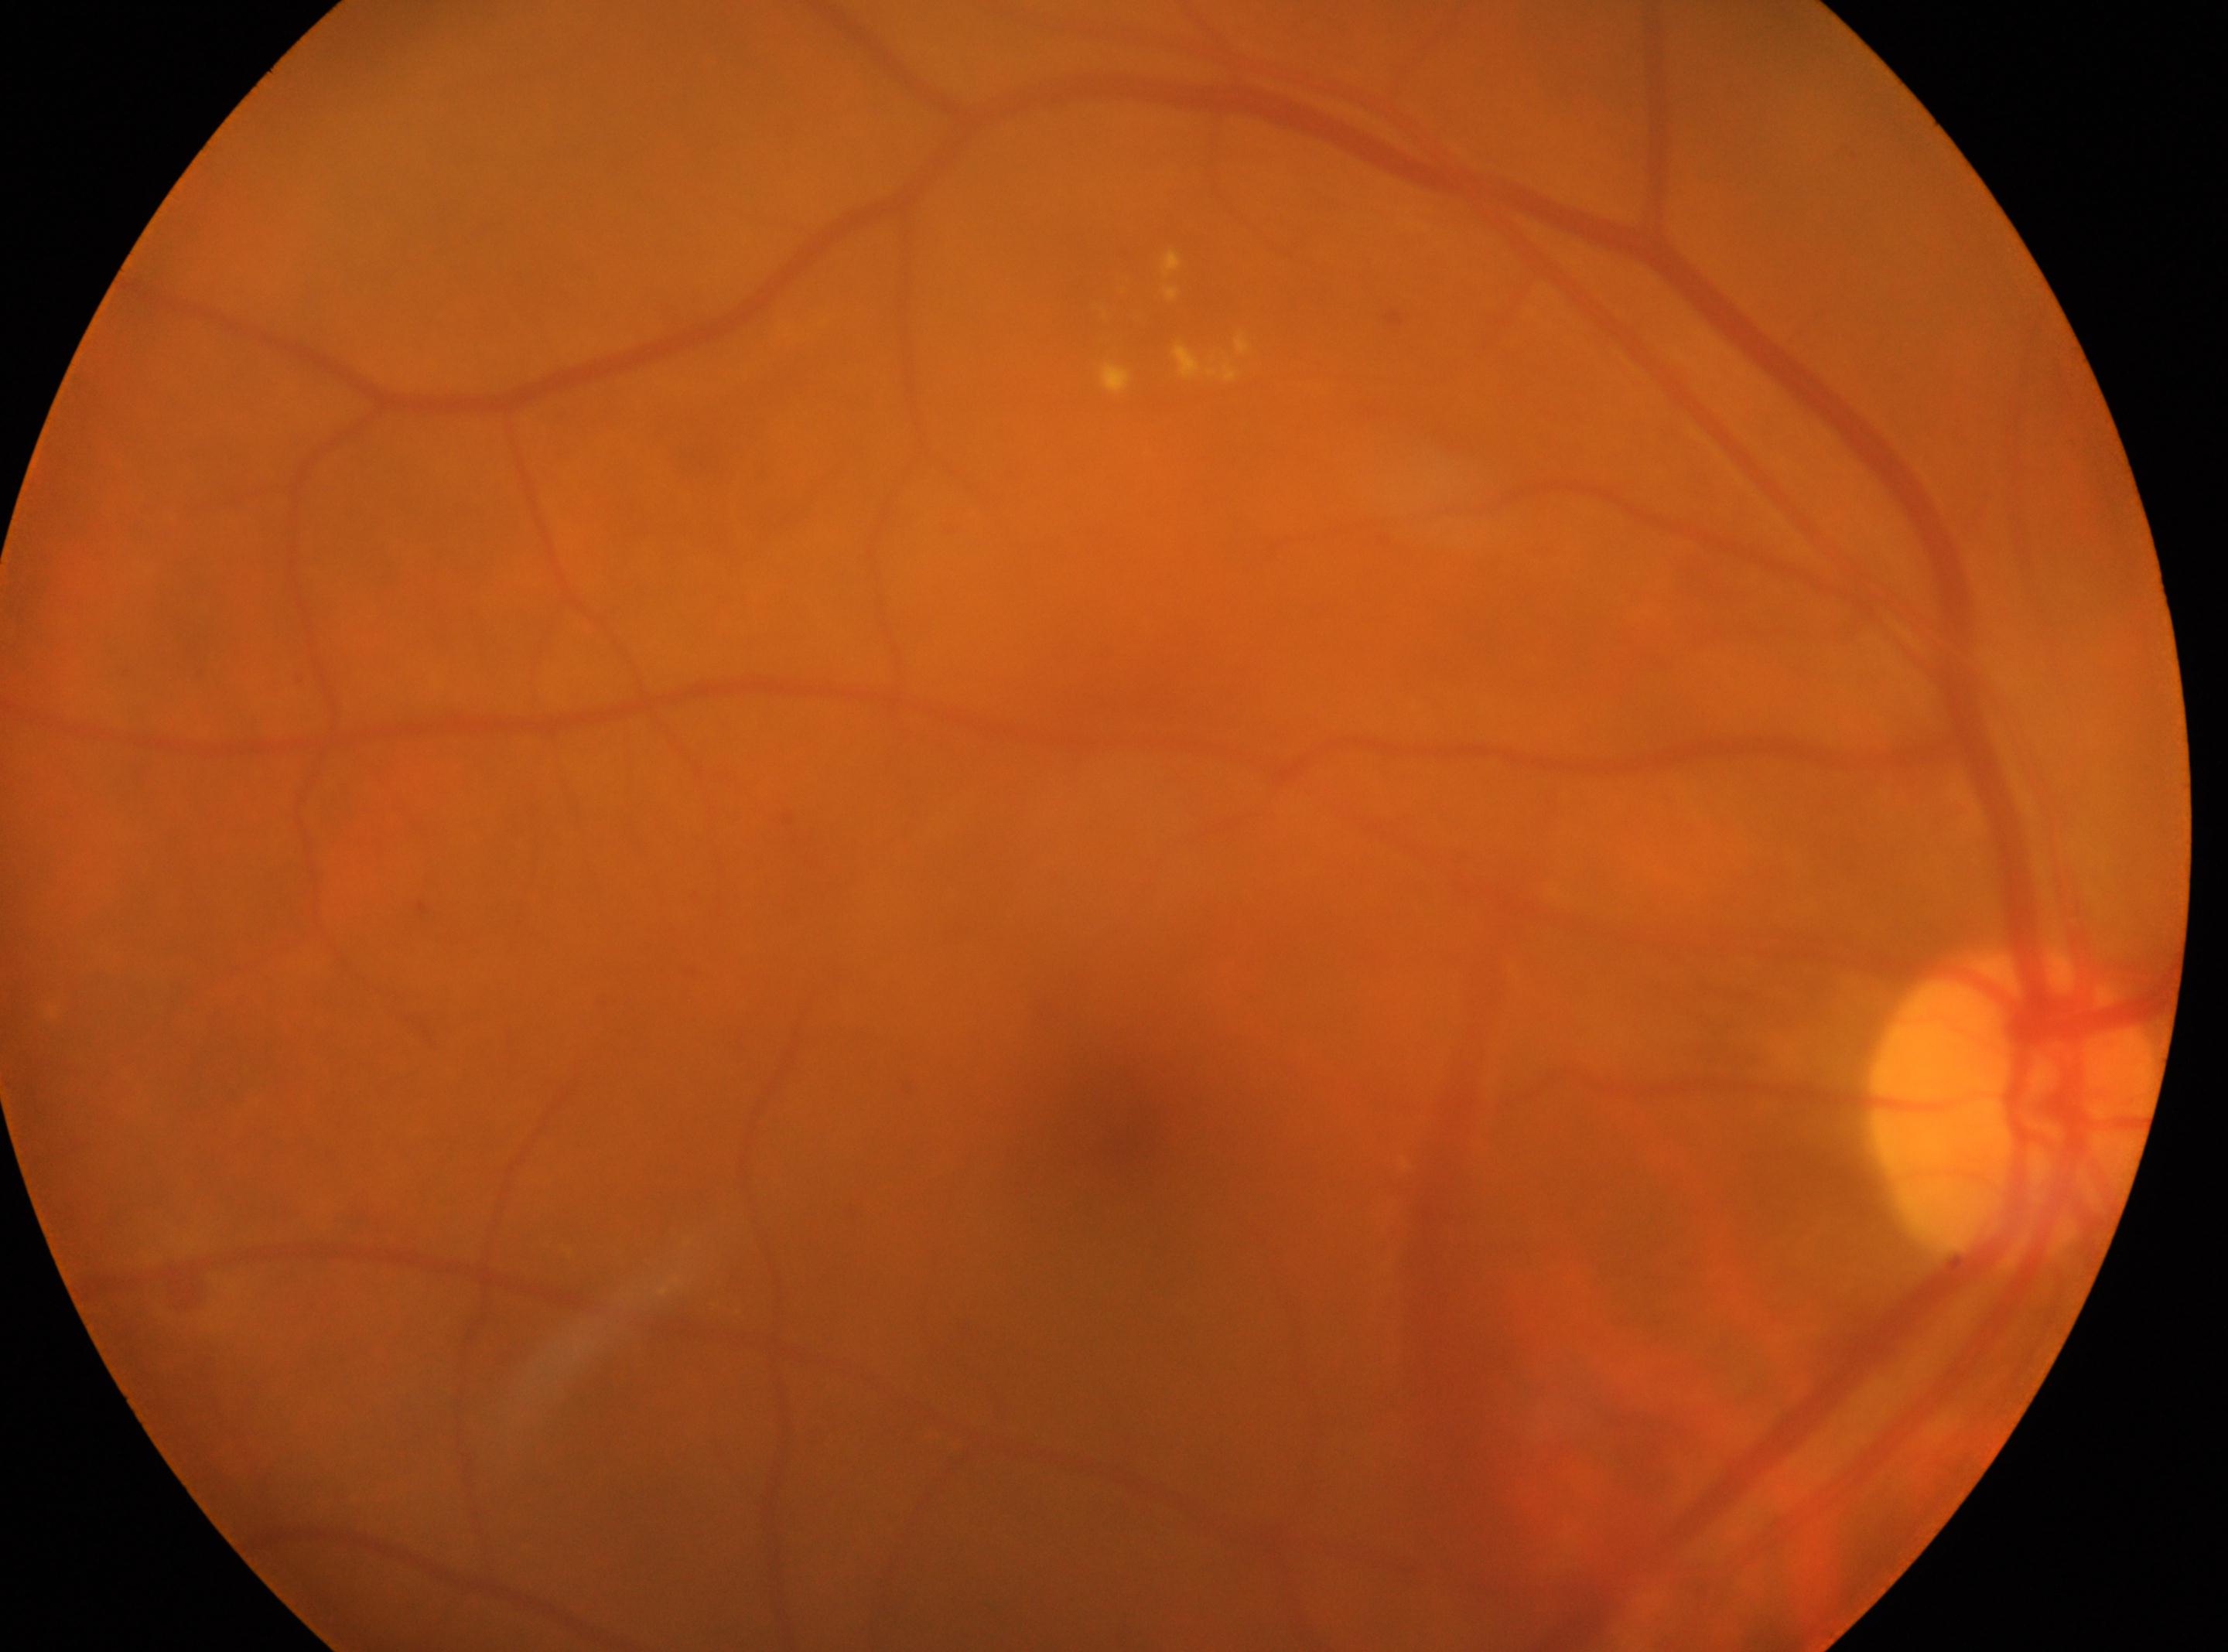
{"eye": "OD", "fovea": "[1140, 1132]", "dr_grade": "2 — more than just microaneurysms but less than severe NPDR", "optic_disc": "[2011, 1108]"}